Fundus photo. 45-degree field of view:
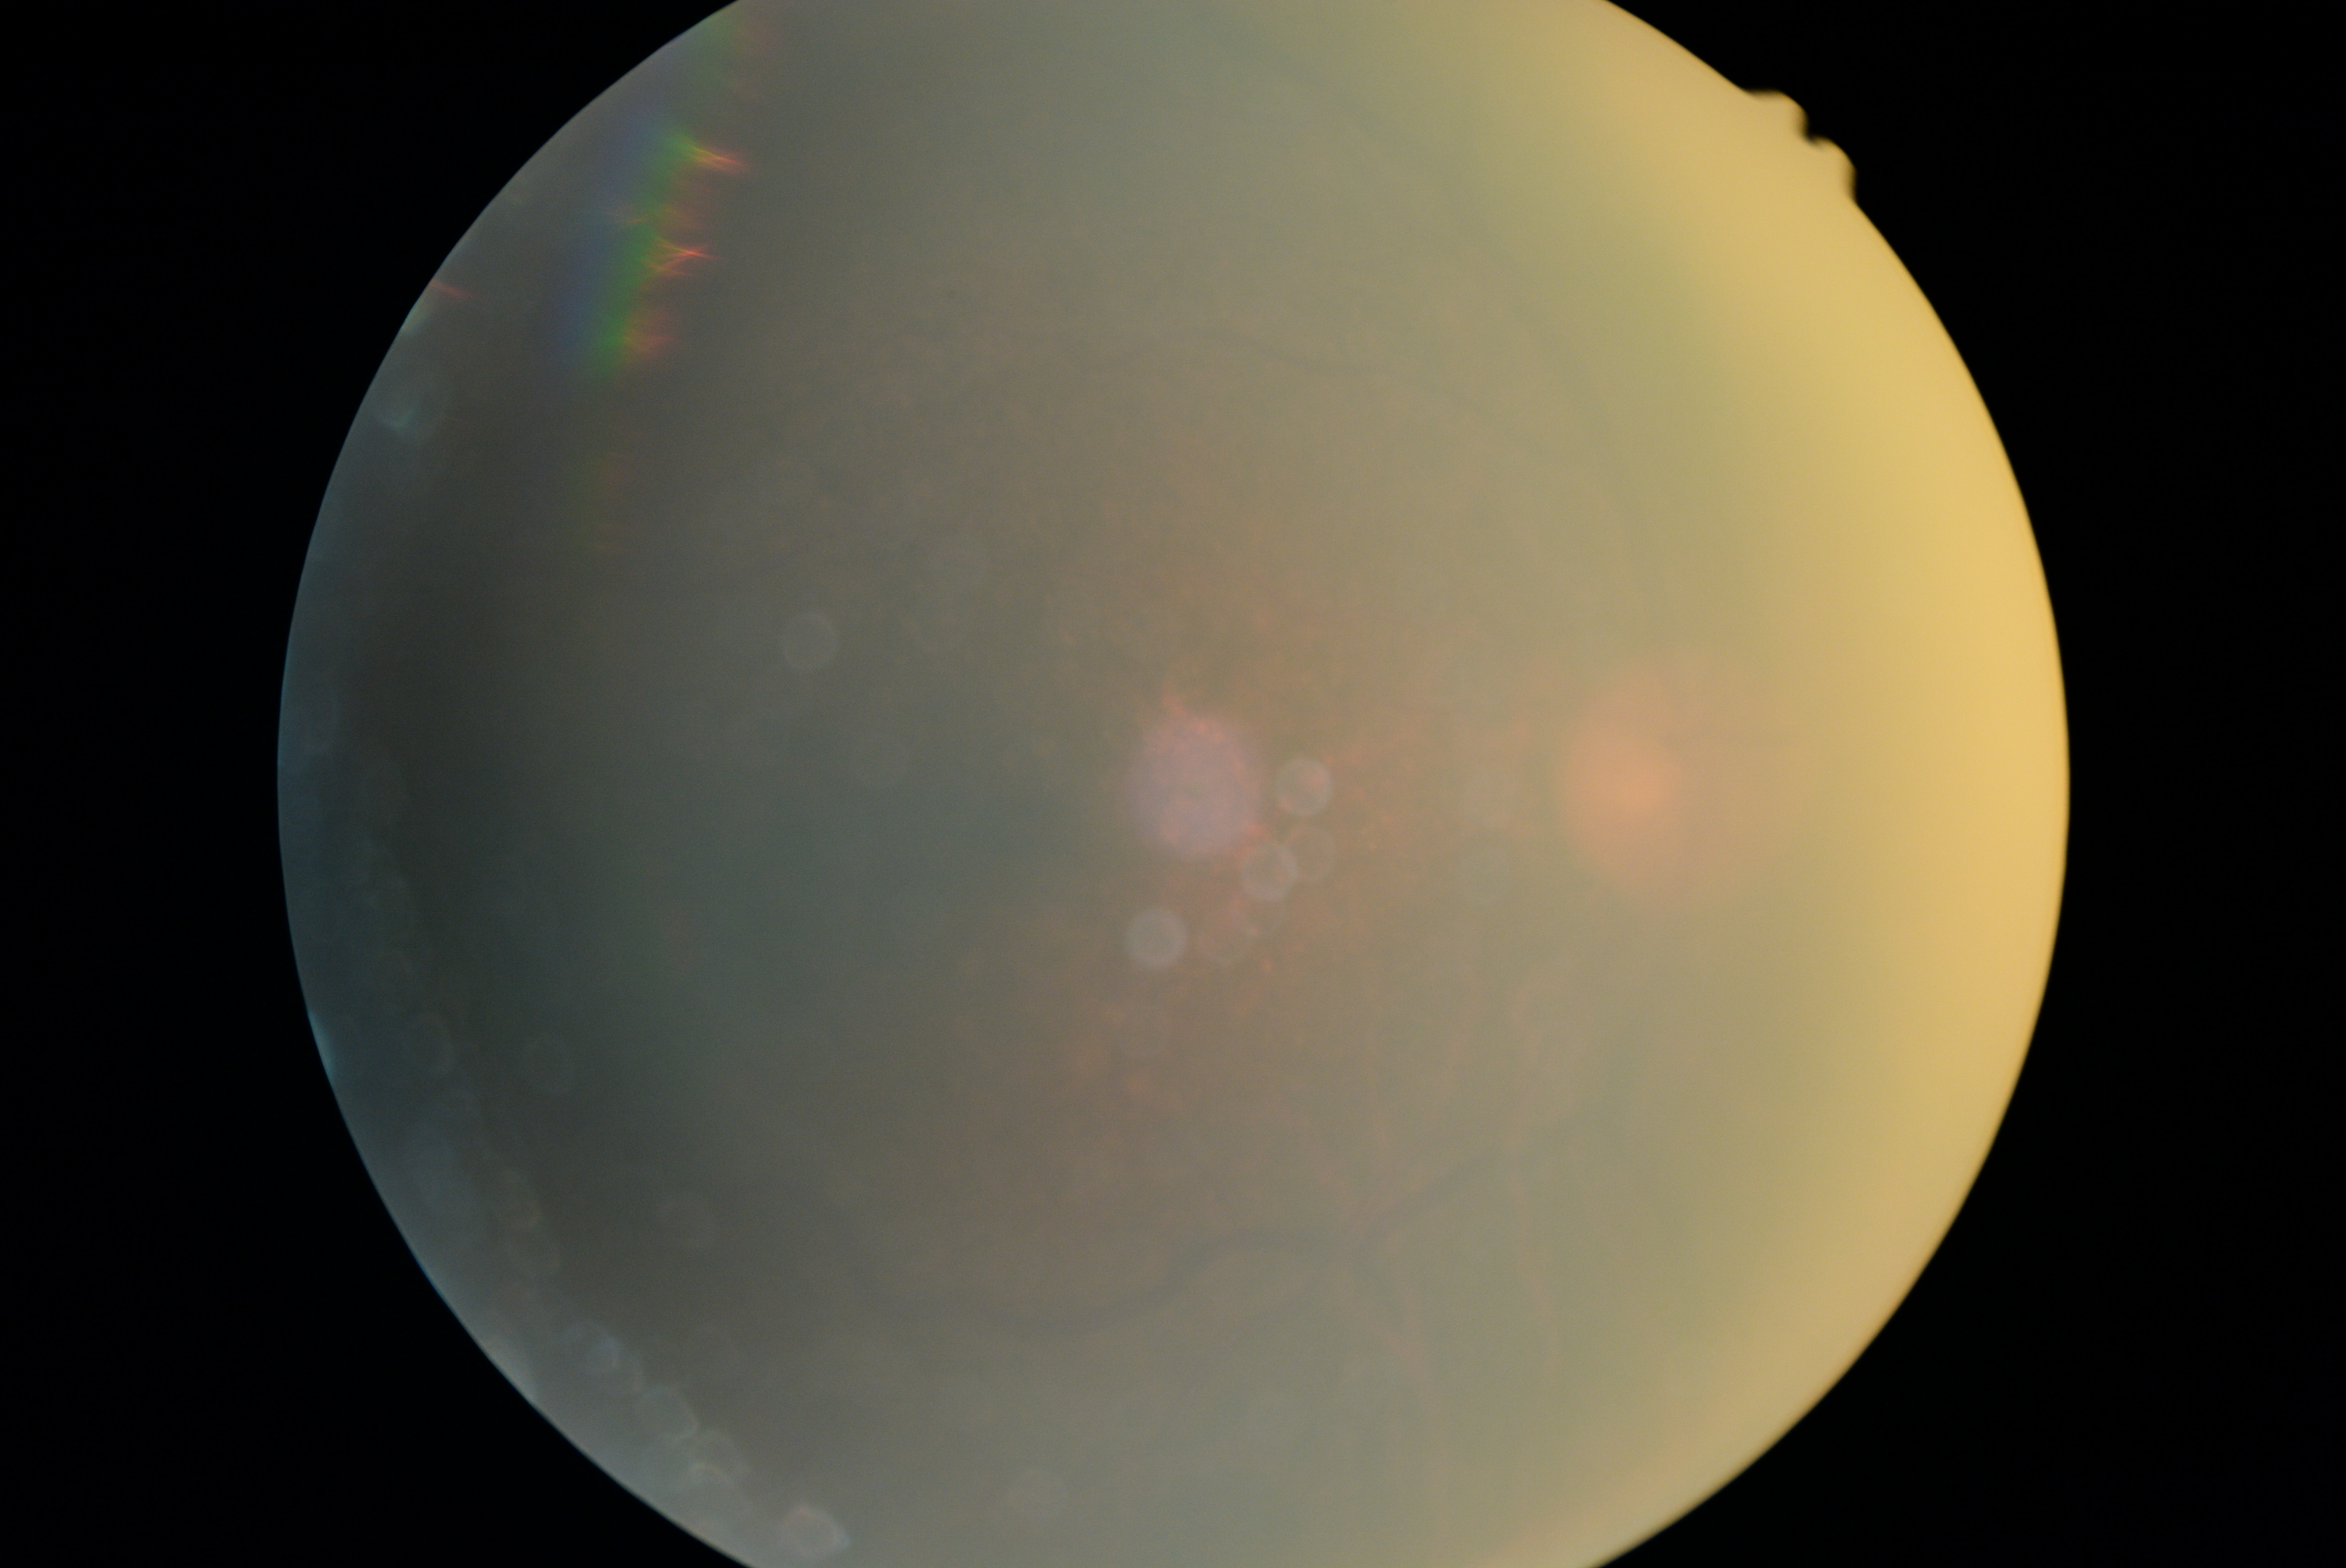 Diabetic retinopathy severity is ungradable due to poor image quality. The image cannot be graded for diabetic retinopathy.